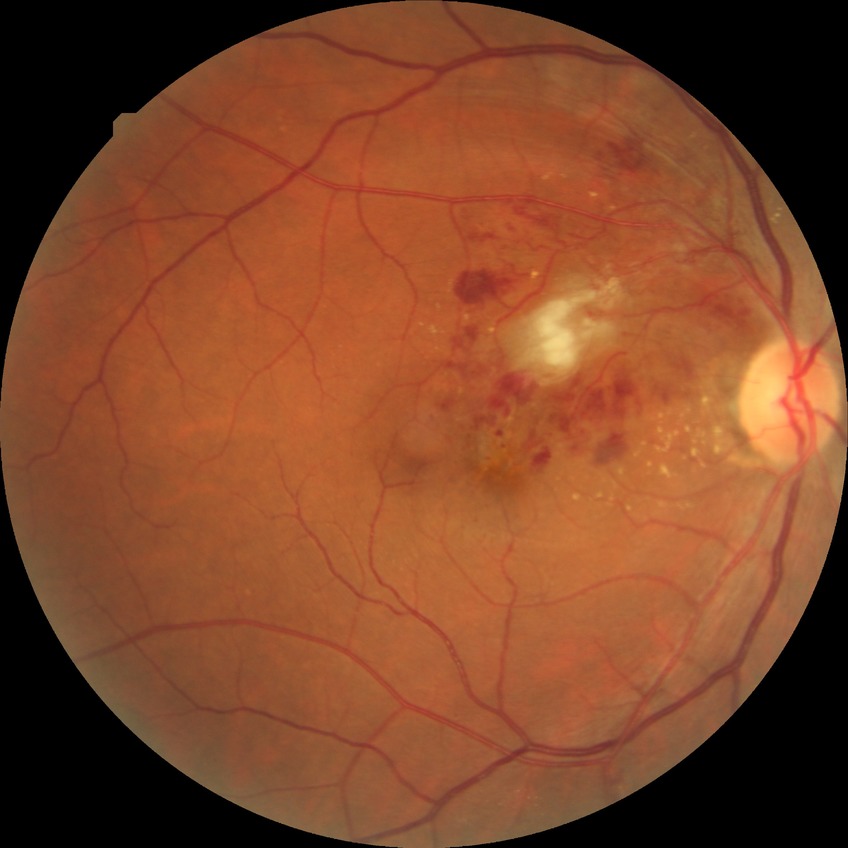 Assessment:
- diabetic retinopathy (DR) — no diabetic retinopathy (NDR)